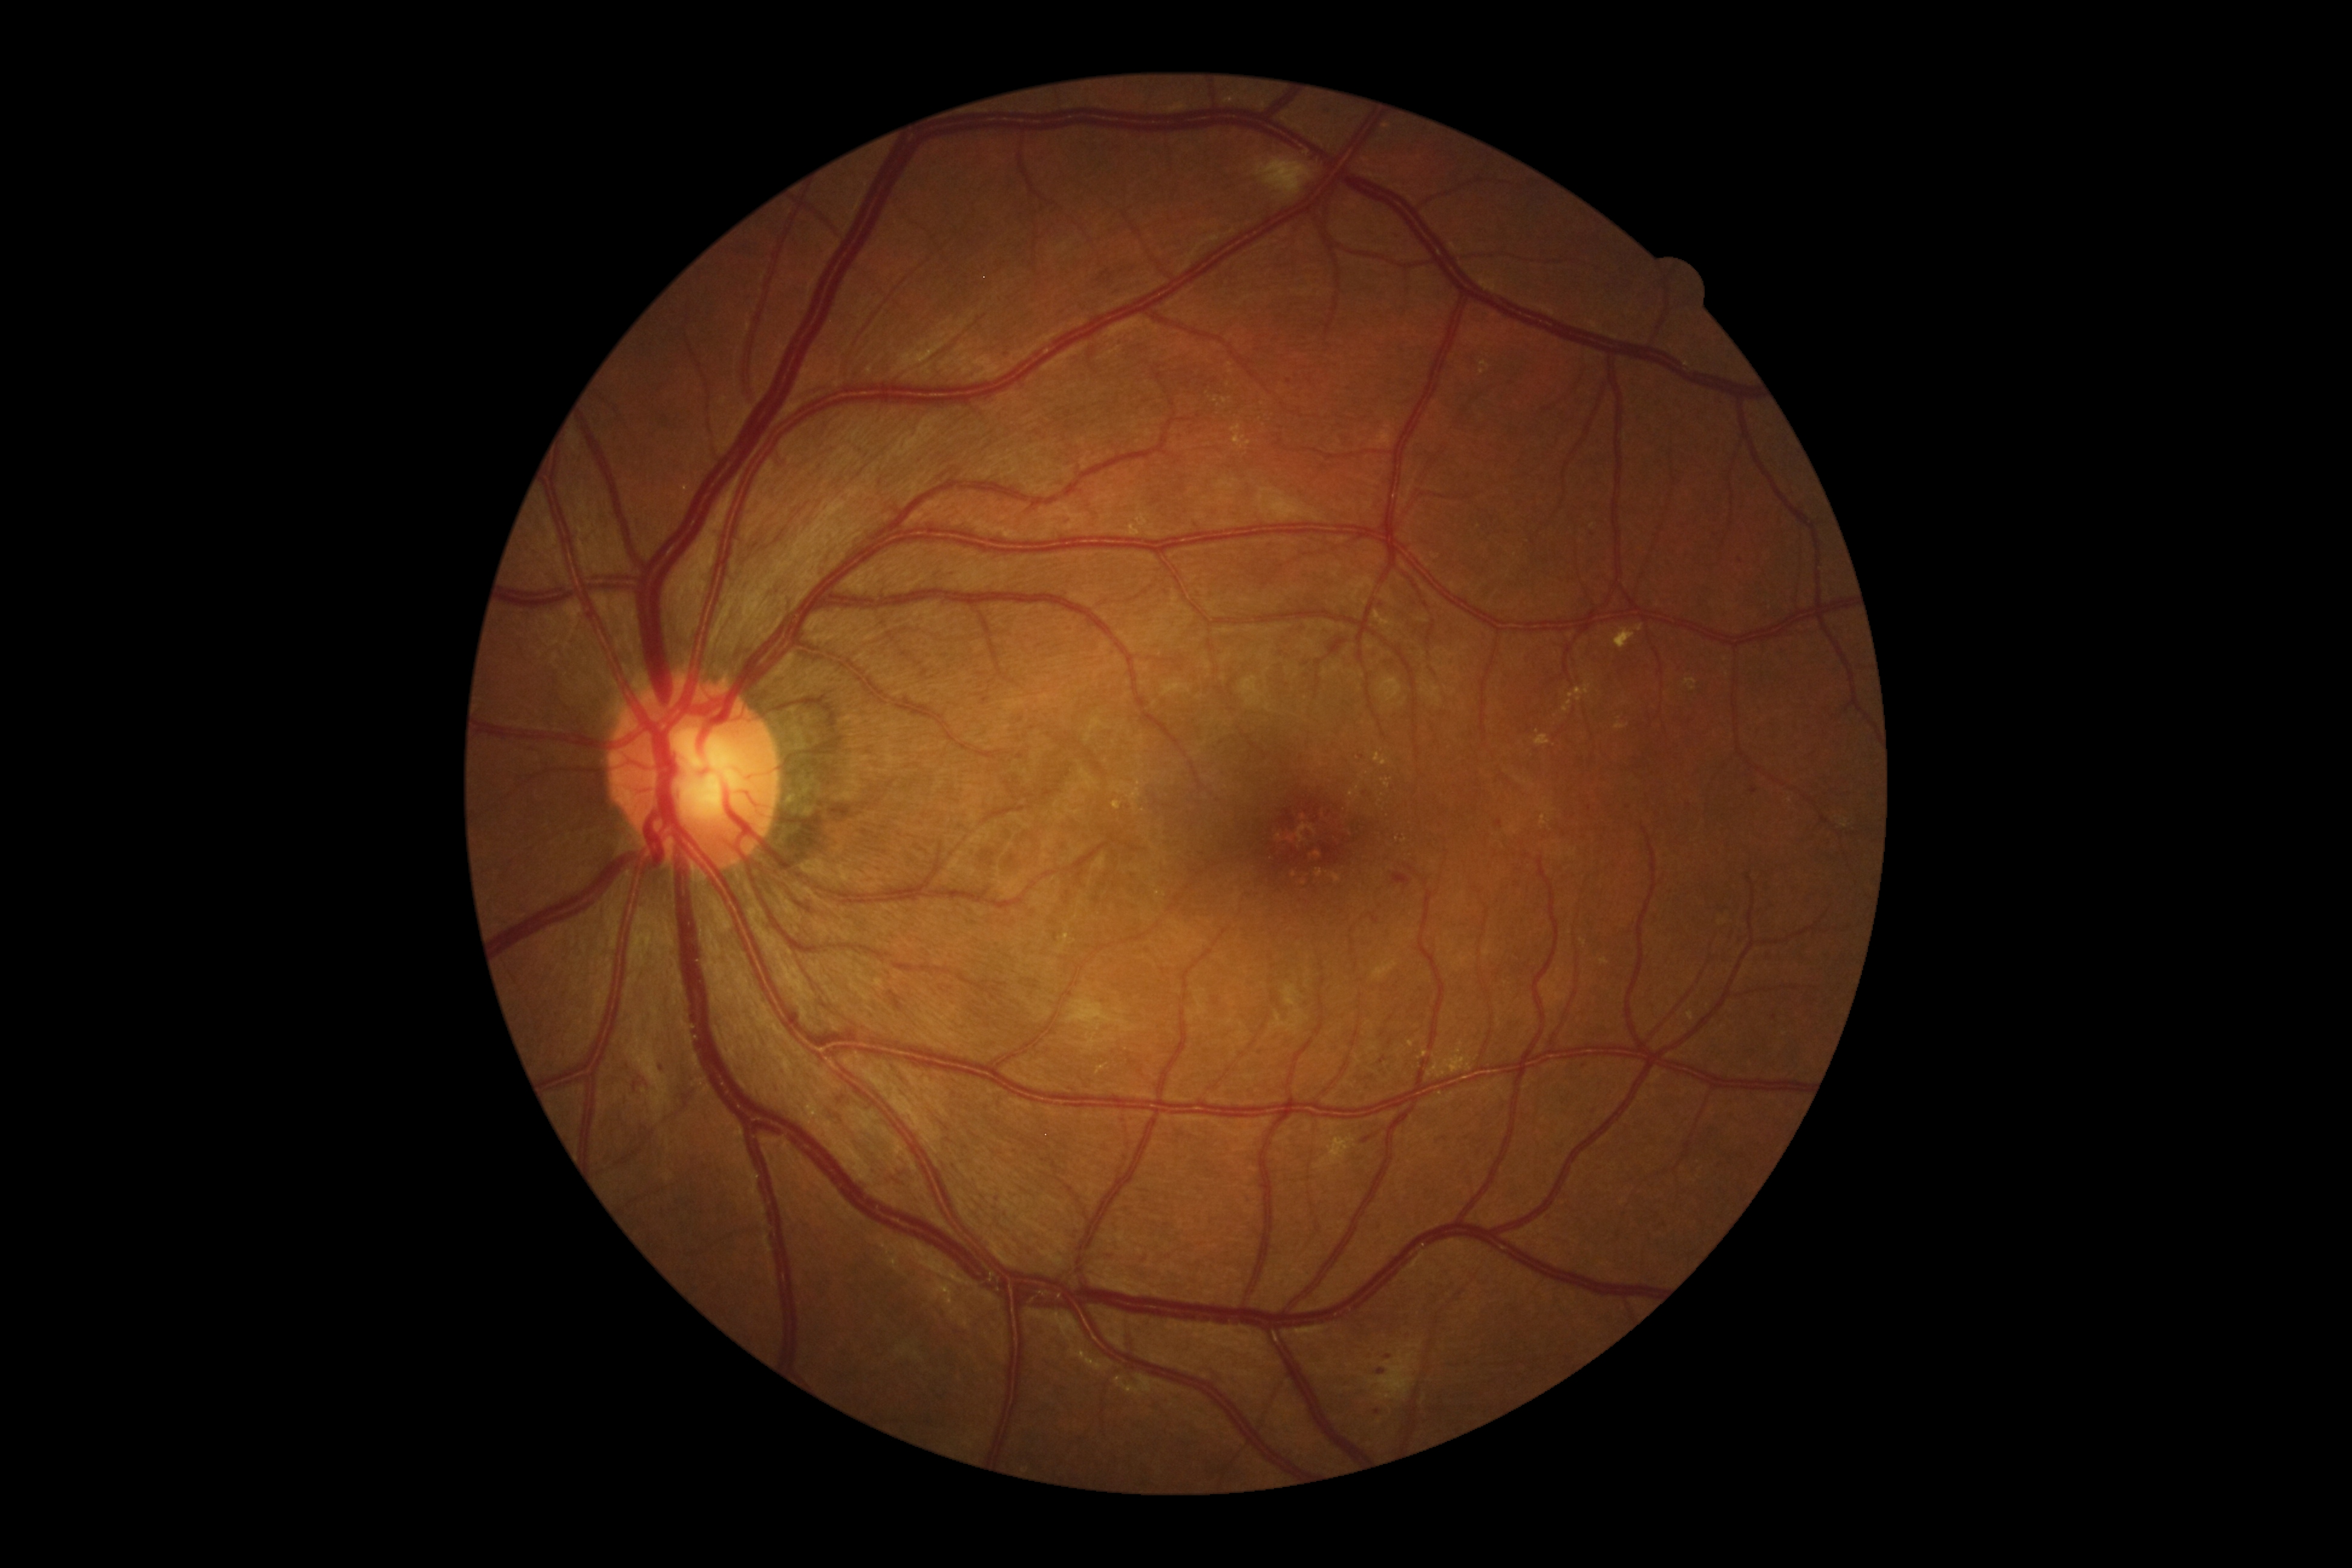
Diabetic retinopathy severity: moderate NPDR (grade 2)
Representative lesions:
* soft exudates: 1254,157,1313,201 | 1367,1351,1417,1400 | 1068,999,1137,1033
* microaneurysms (more not shown): 791,1010,804,1022 | 983,697,990,706 | 1377,1369,1385,1375 | 1751,788,1759,795 | 1393,873,1411,890 | 838,1096,845,1104 | 1496,820,1502,828
* Microaneurysms (small, approximate centers) near x=1775 y=1018 | x=1377 y=1412 | x=1096 y=901 | x=1289 y=381 | x=1689 y=806 | x=662 y=1068 | x=1628 y=808 | x=1590 y=808 | x=1741 y=562
* hard exudates: 1535,735,1552,748 | 1427,1042,1472,1079 | 1027,1310,1115,1373 | 1231,425,1250,448 | 1567,682,1592,702 | 1613,625,1644,649 | 1116,1375,1165,1397
* hemorrhages: 887,991,903,1012 | 633,1082,639,1091
* Hemorrhages (small, approximate centers) near x=1367 y=1140